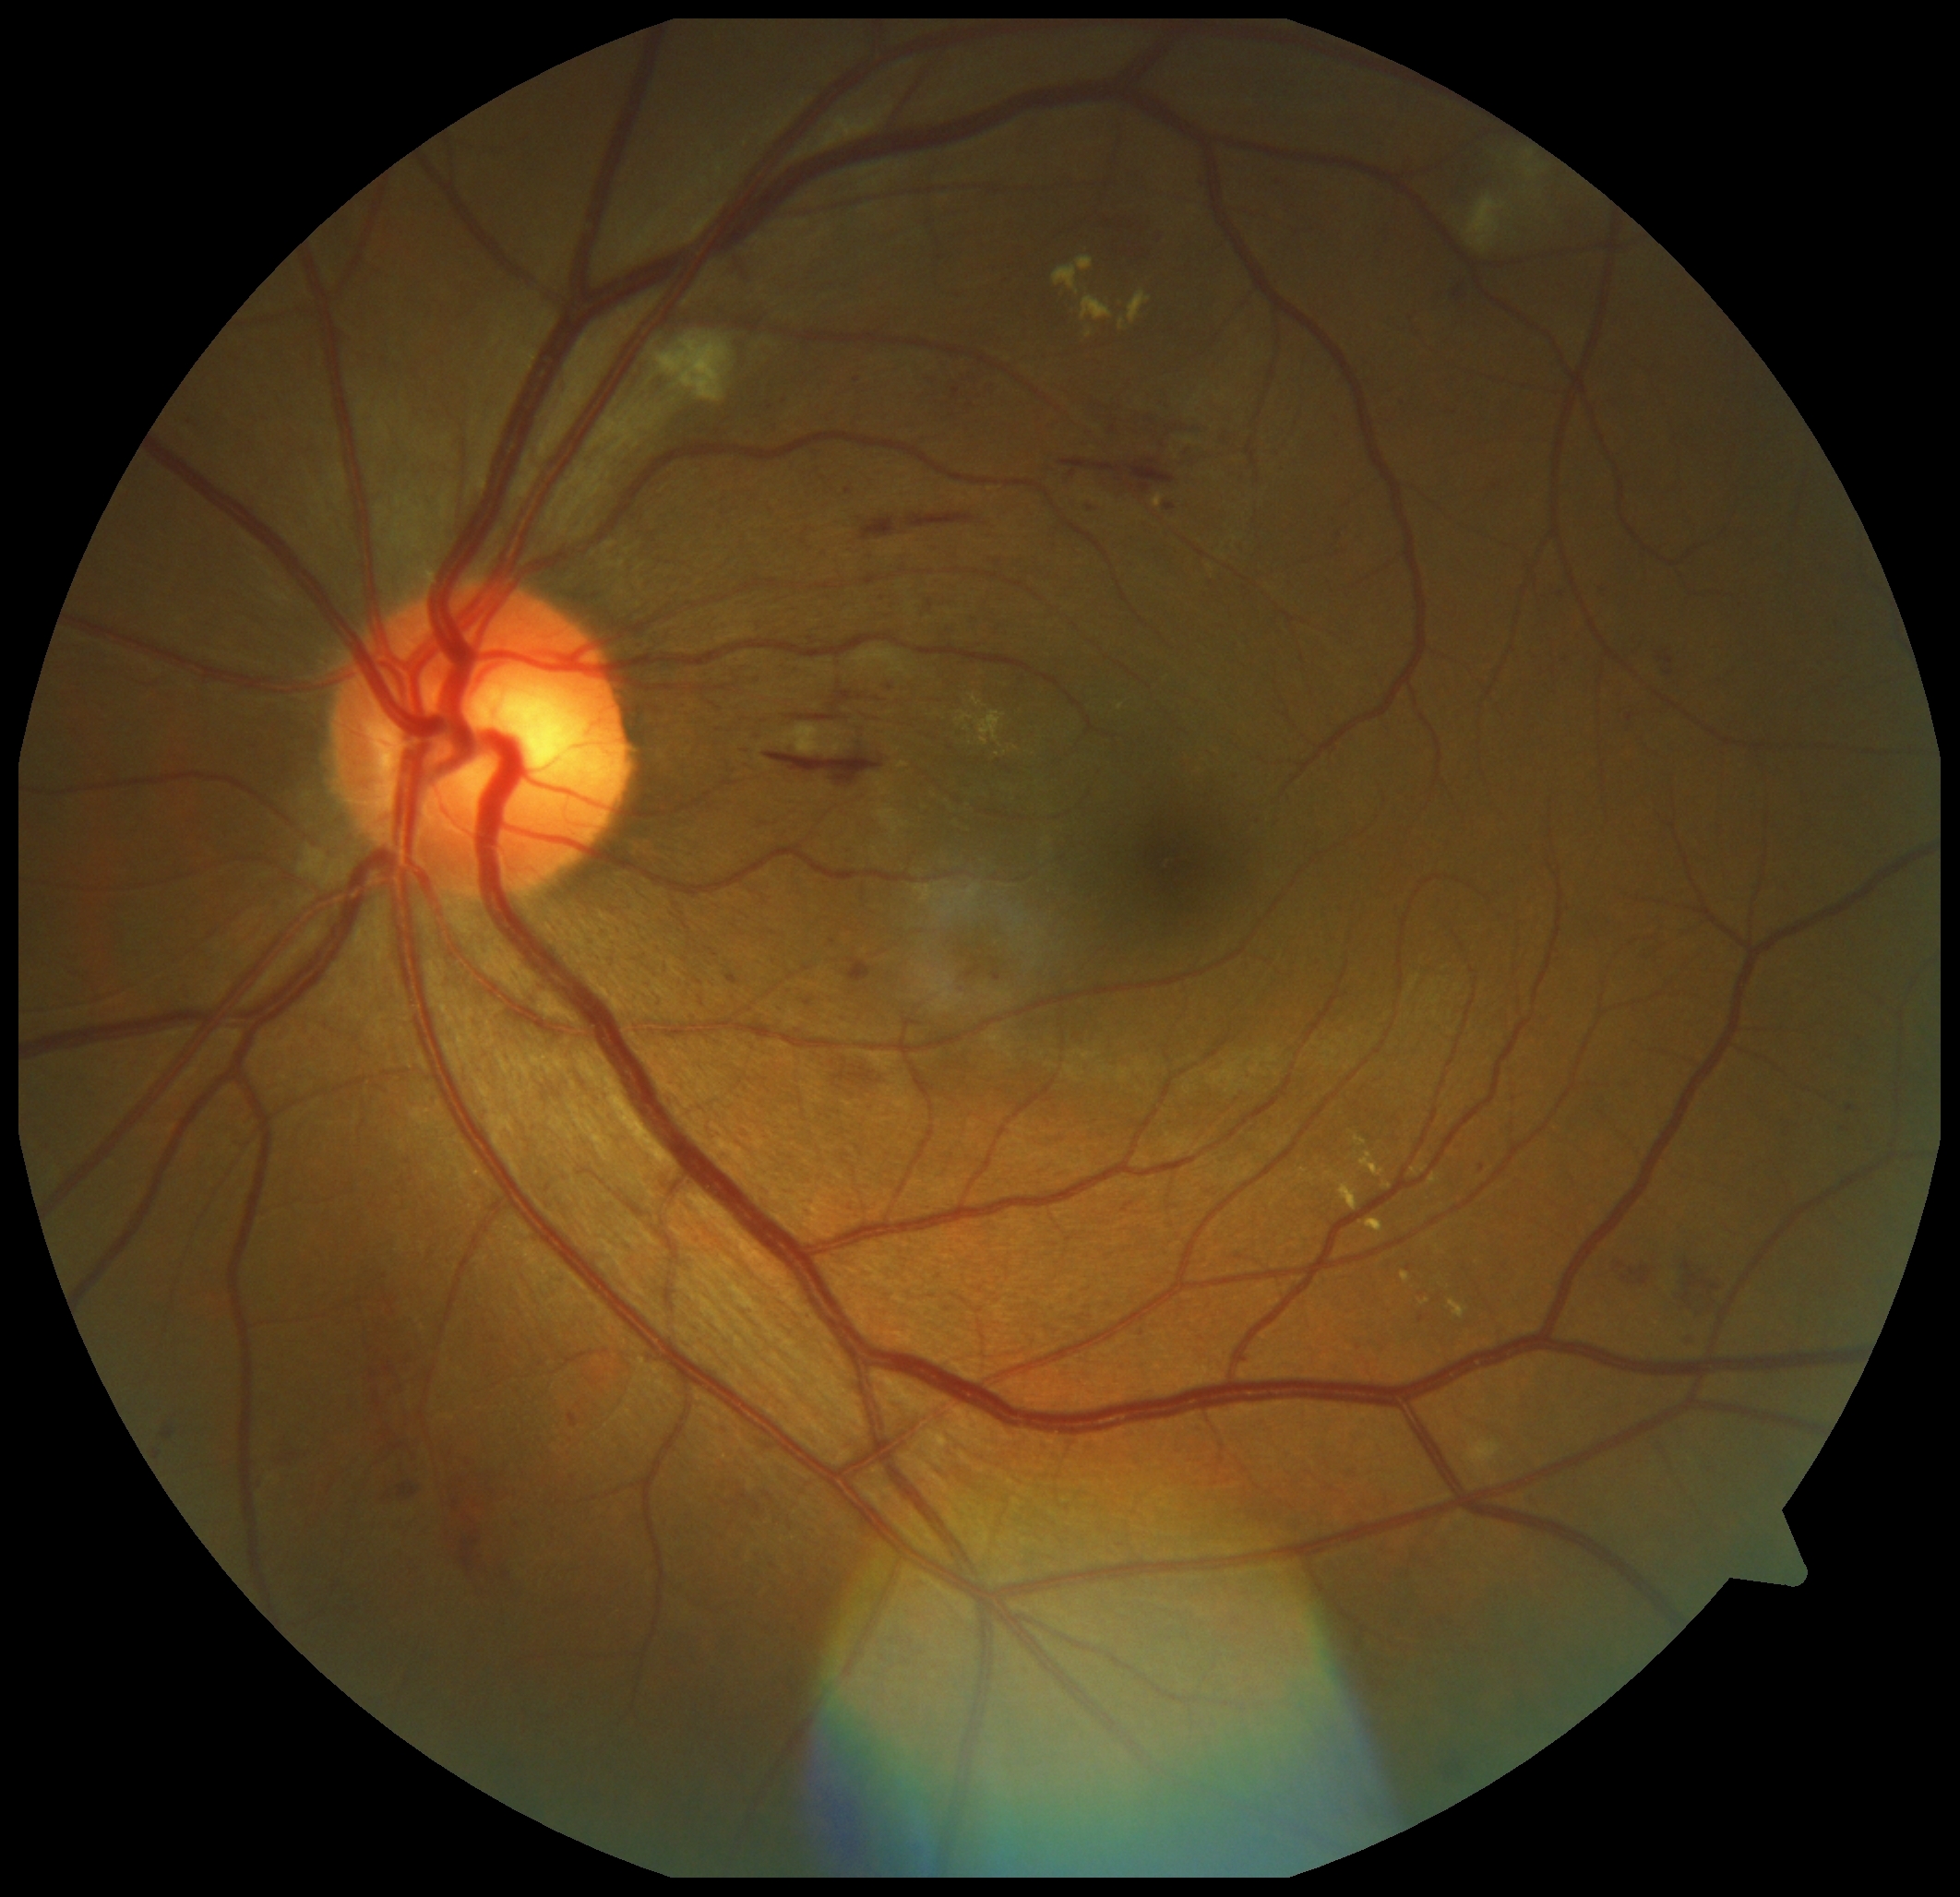 DR severity: grade 2 — more than just microaneurysms but less than severe NPDR. EXs include those at <region>958, 711, 973, 723</region>, <region>1119, 319, 1125, 330</region>, <region>1420, 1299, 1431, 1306</region>, <region>1429, 1175, 1440, 1187</region>, <region>1339, 1183, 1357, 1211</region>, <region>1401, 1272, 1410, 1284</region>, <region>974, 711, 1007, 747</region>, <region>1082, 297, 1114, 321</region>, <region>1366, 1220, 1384, 1234</region>. Additional small EXs near (1016; 749). MAs include those at <region>853, 376, 858, 386</region>, <region>1606, 580, 1611, 593</region>, <region>257, 1475, 268, 1490</region>, <region>952, 388, 960, 399</region>, <region>569, 1414, 579, 1428</region>, <region>1682, 1334, 1690, 1350</region>, <region>1480, 1165, 1486, 1173</region>, <region>1165, 504, 1176, 511</region>. Additional small MAs near (1850; 1108), (807; 1003), (890; 688).